Fundus photograph cropped around the optic nerve head, image size 355x355.
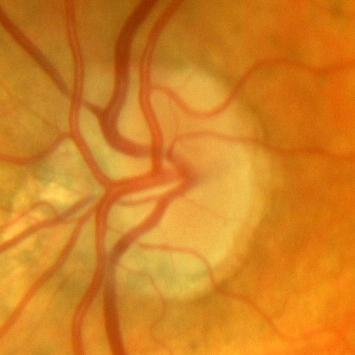
Q: Is there glaucomatous optic neuropathy?
A: No glaucoma.